45° field of view; image size 2212x1659; fundus photo.
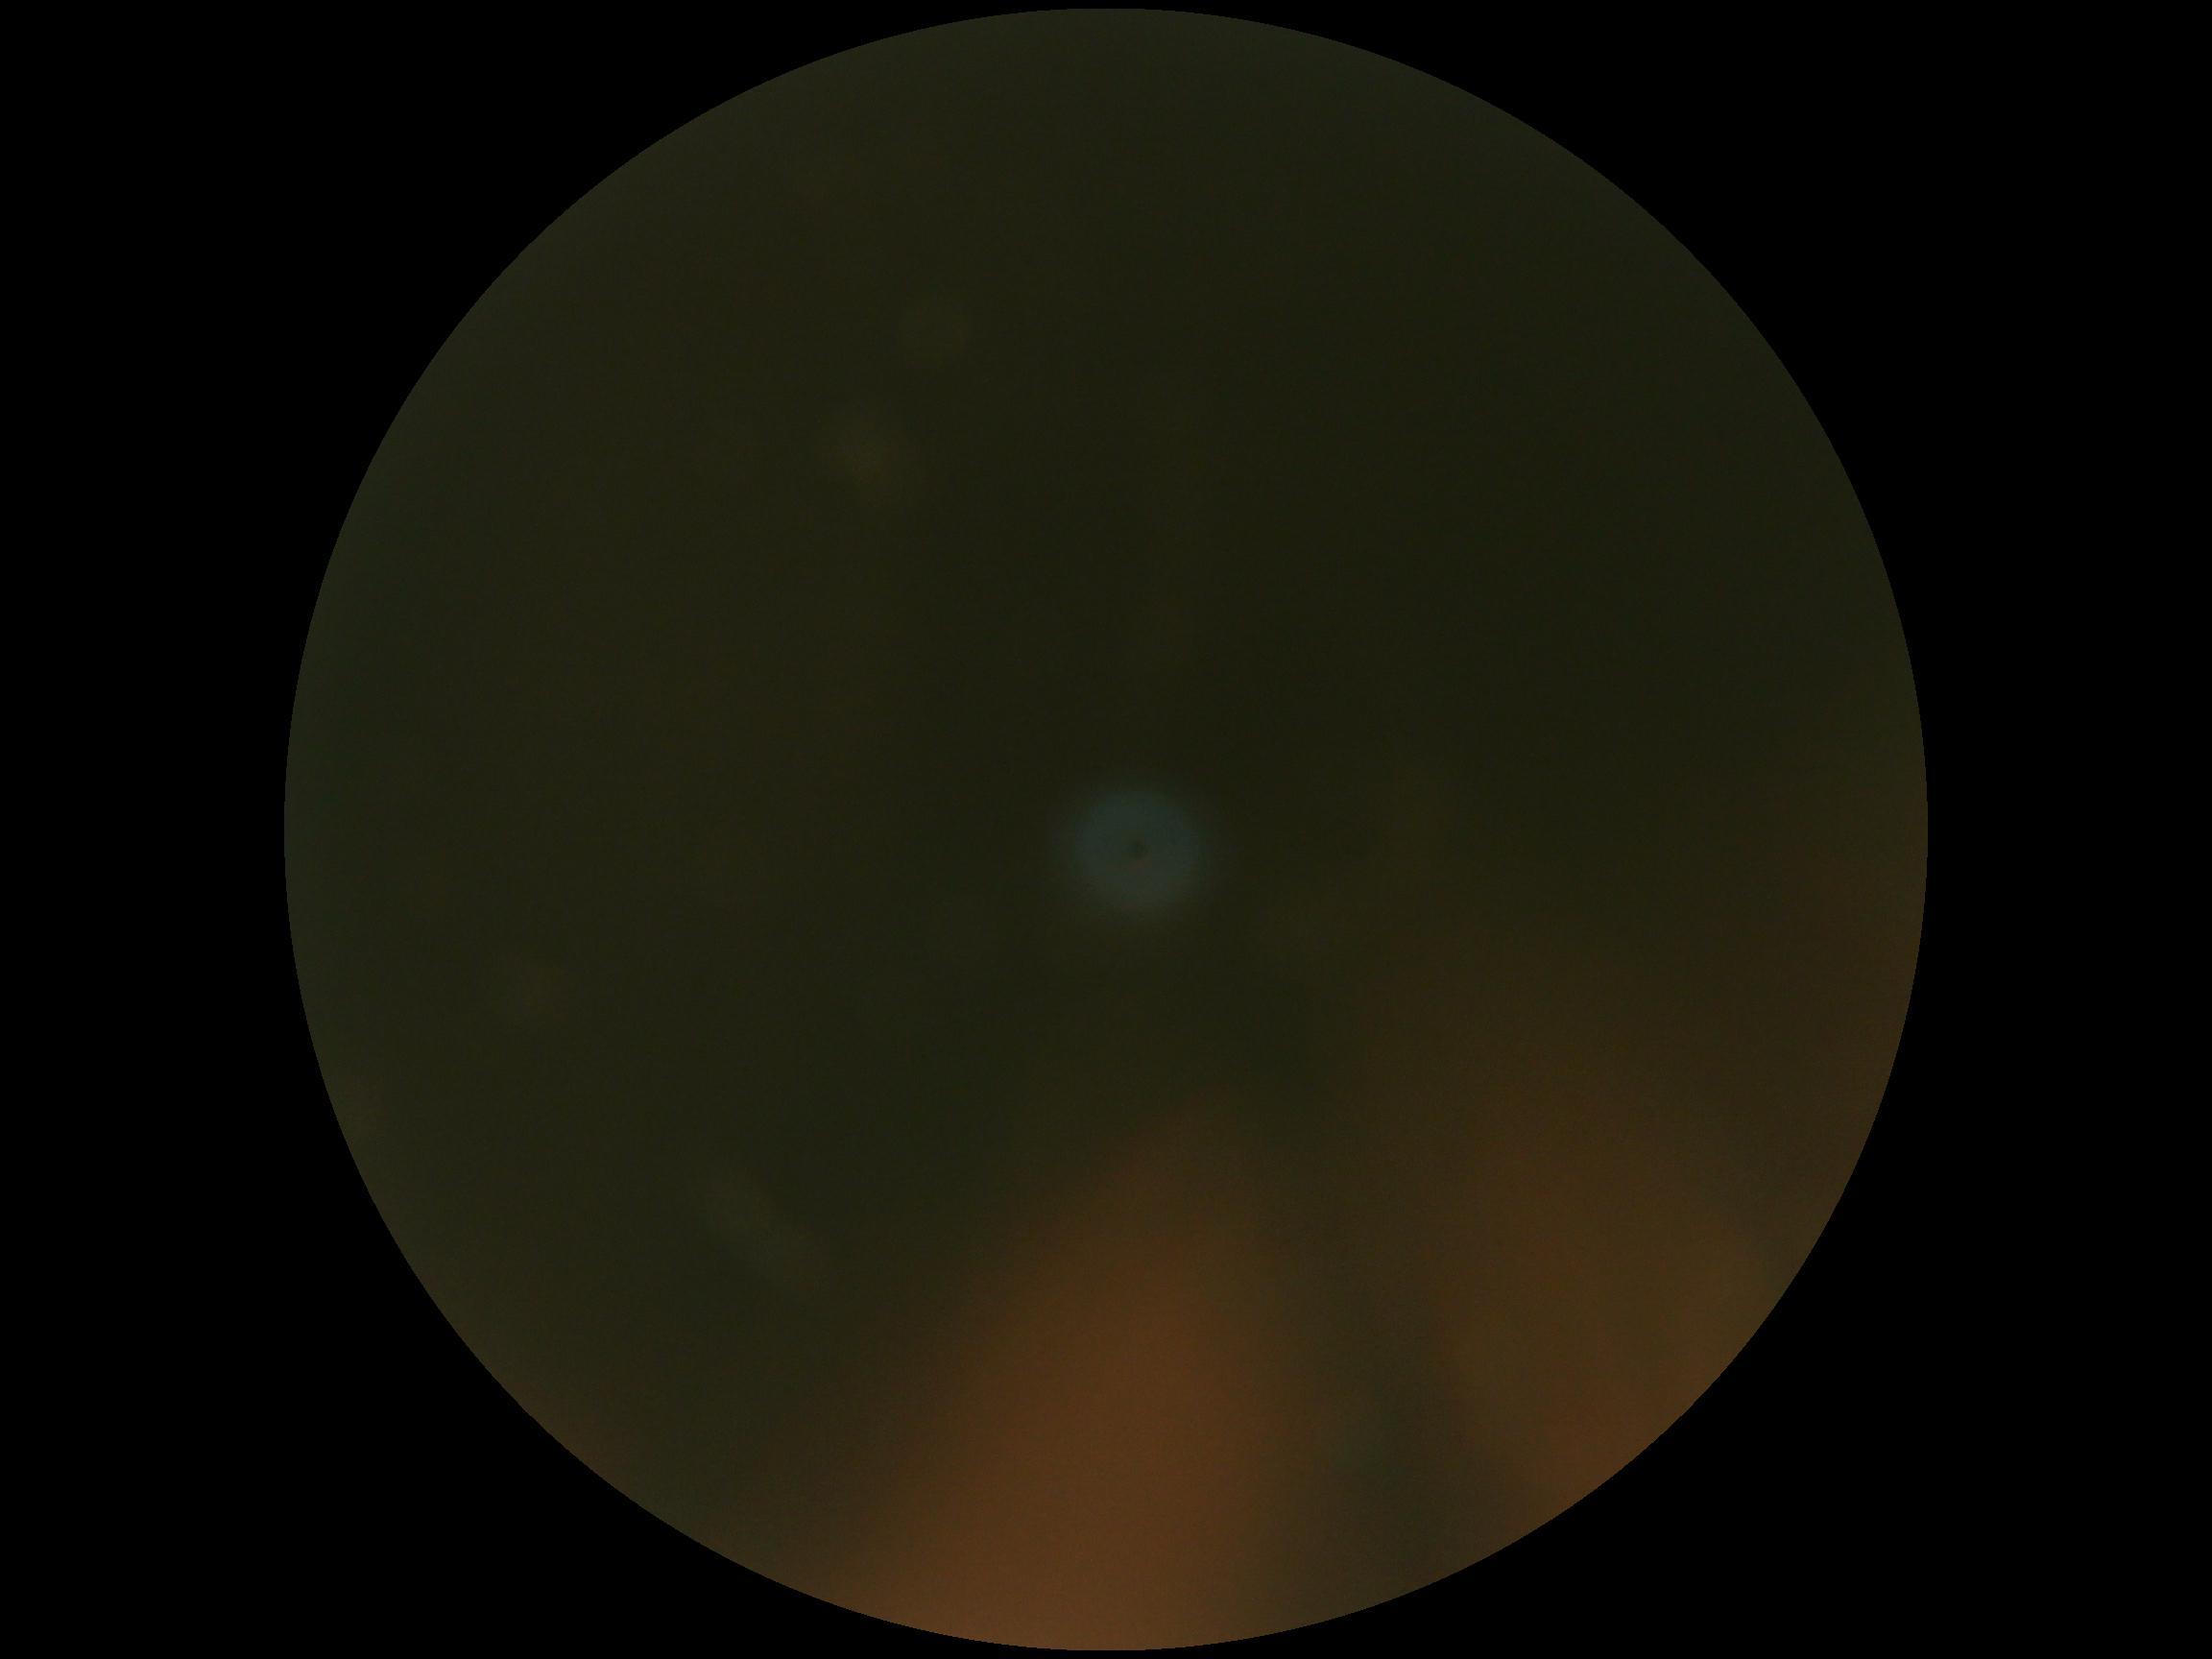 DR: ungradable due to poor image quality. Quality too poor to assess for DR.